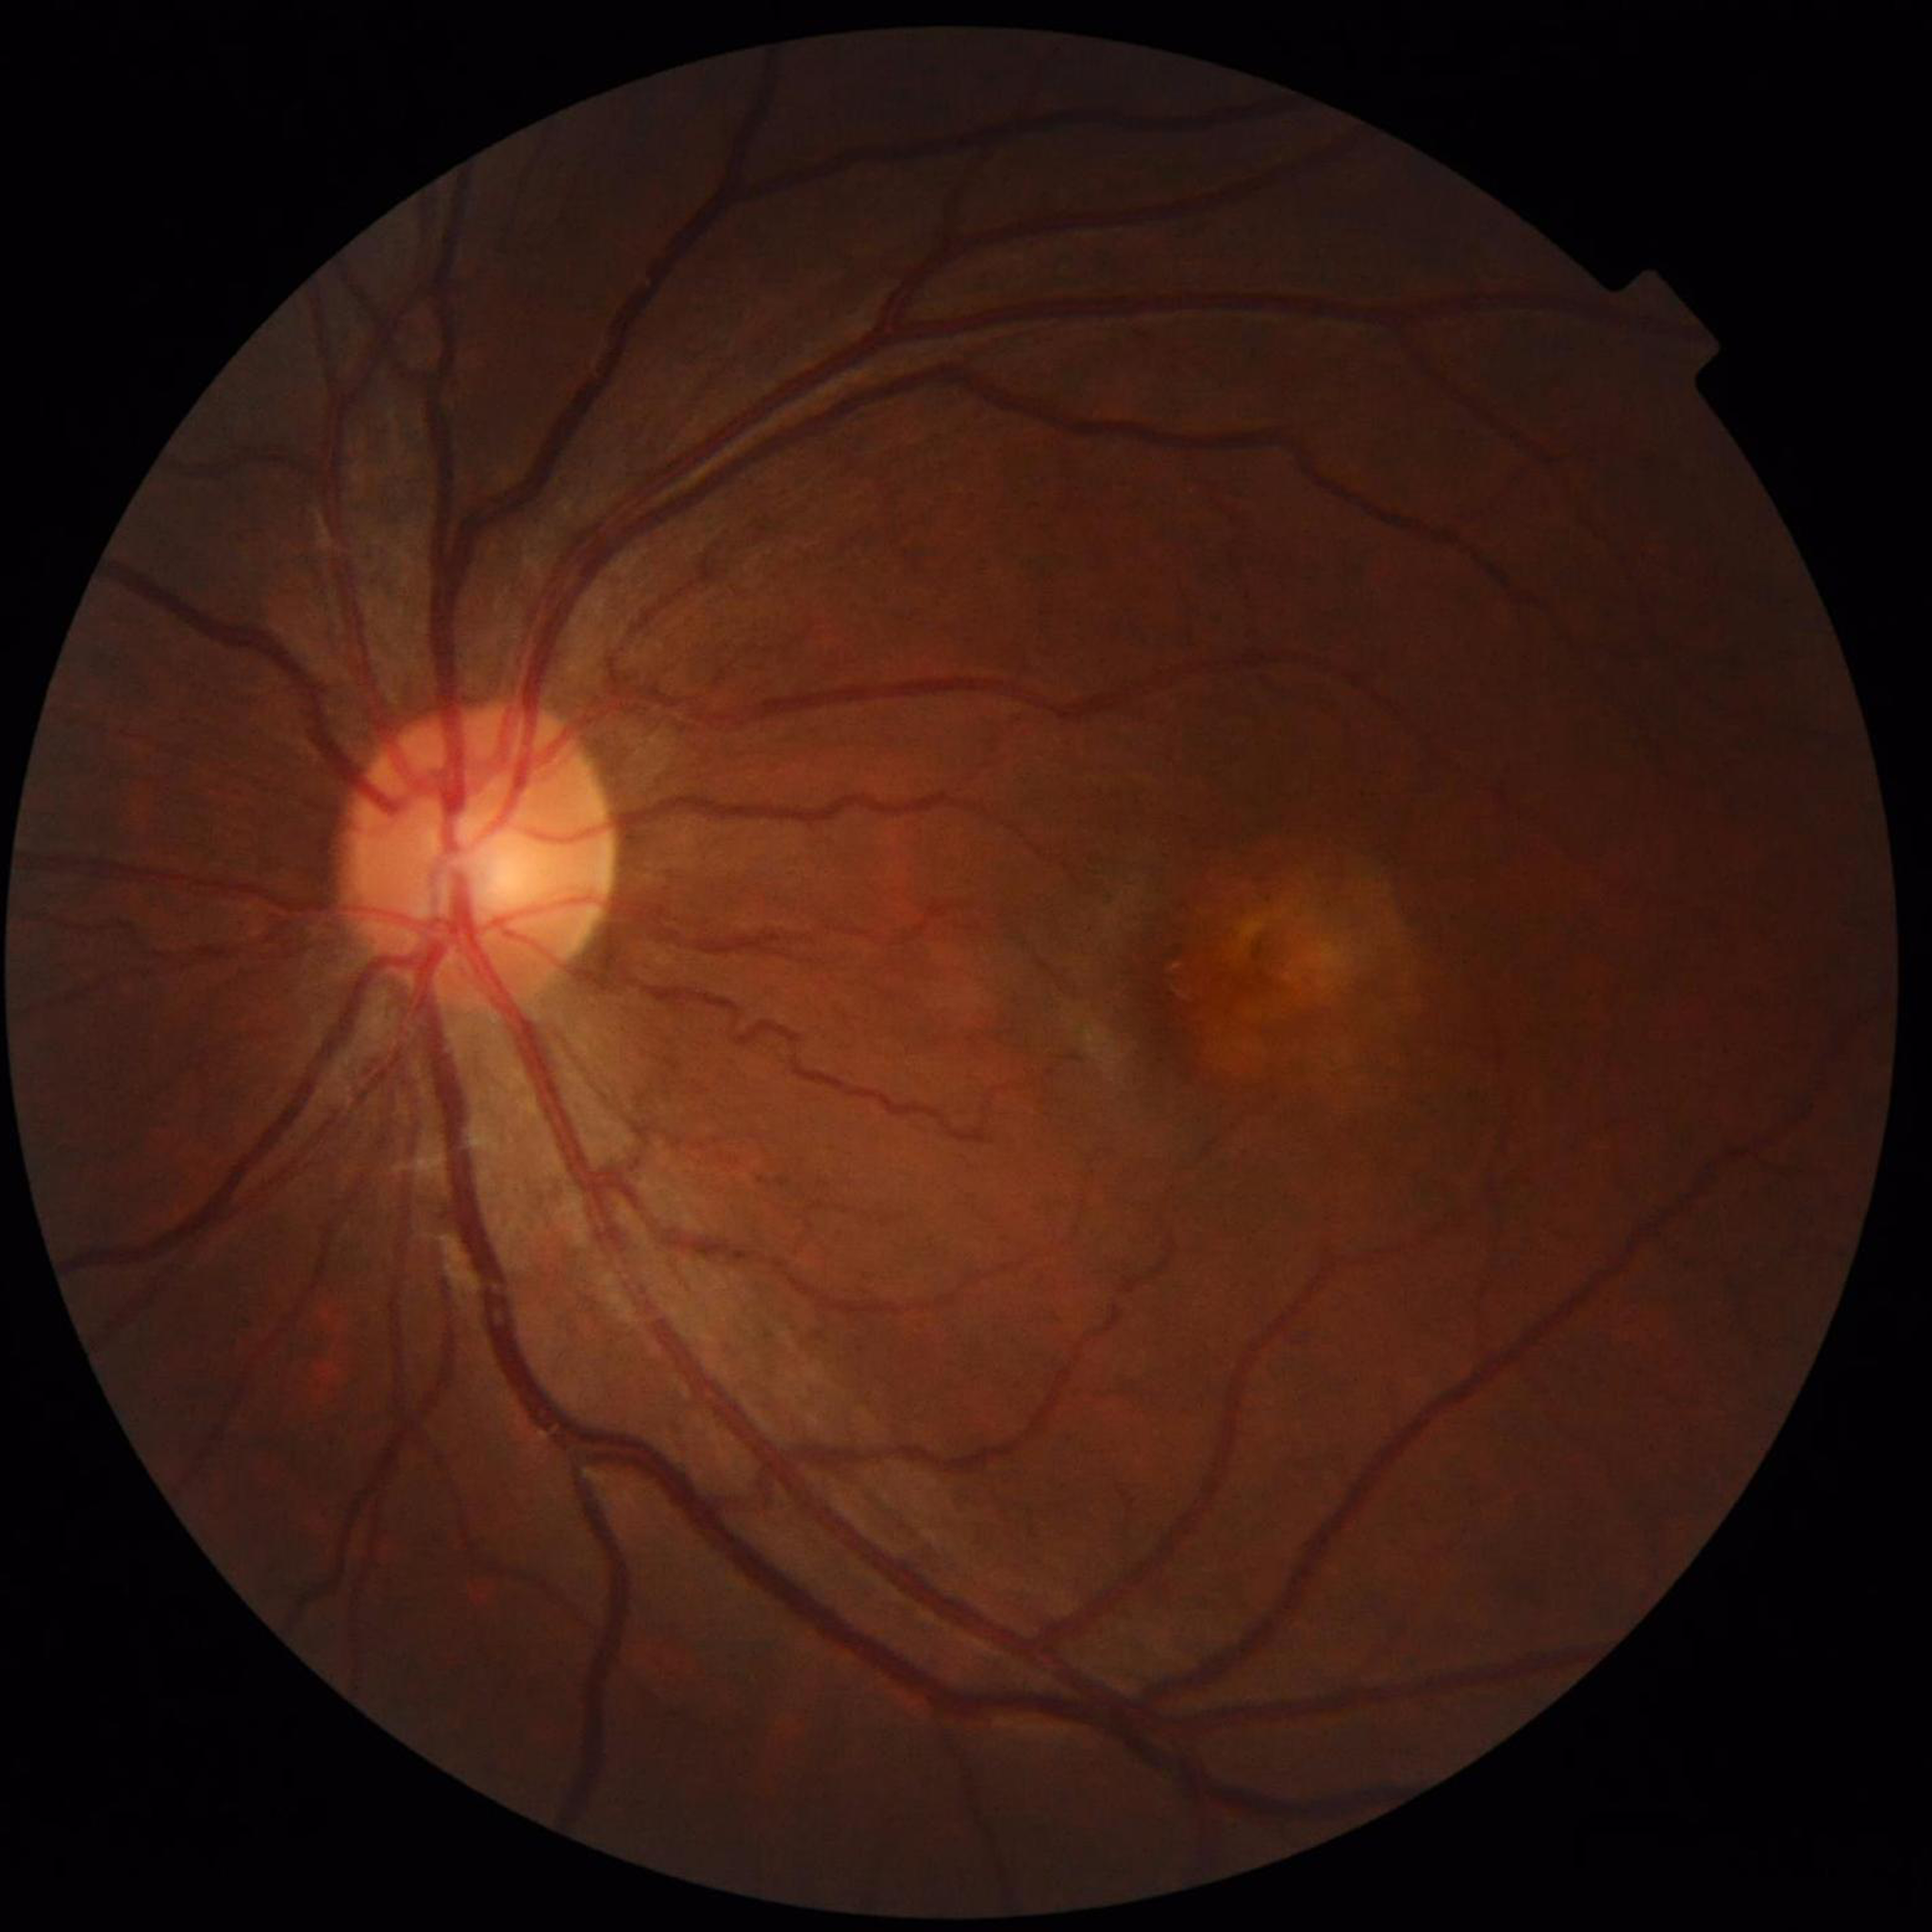 Diagnosed with age-related macular degeneration.